CFP — 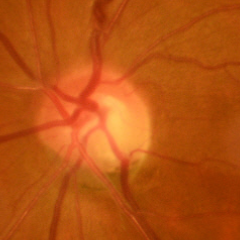

Findings consistent with early-stage glaucoma.